45-degree field of view.
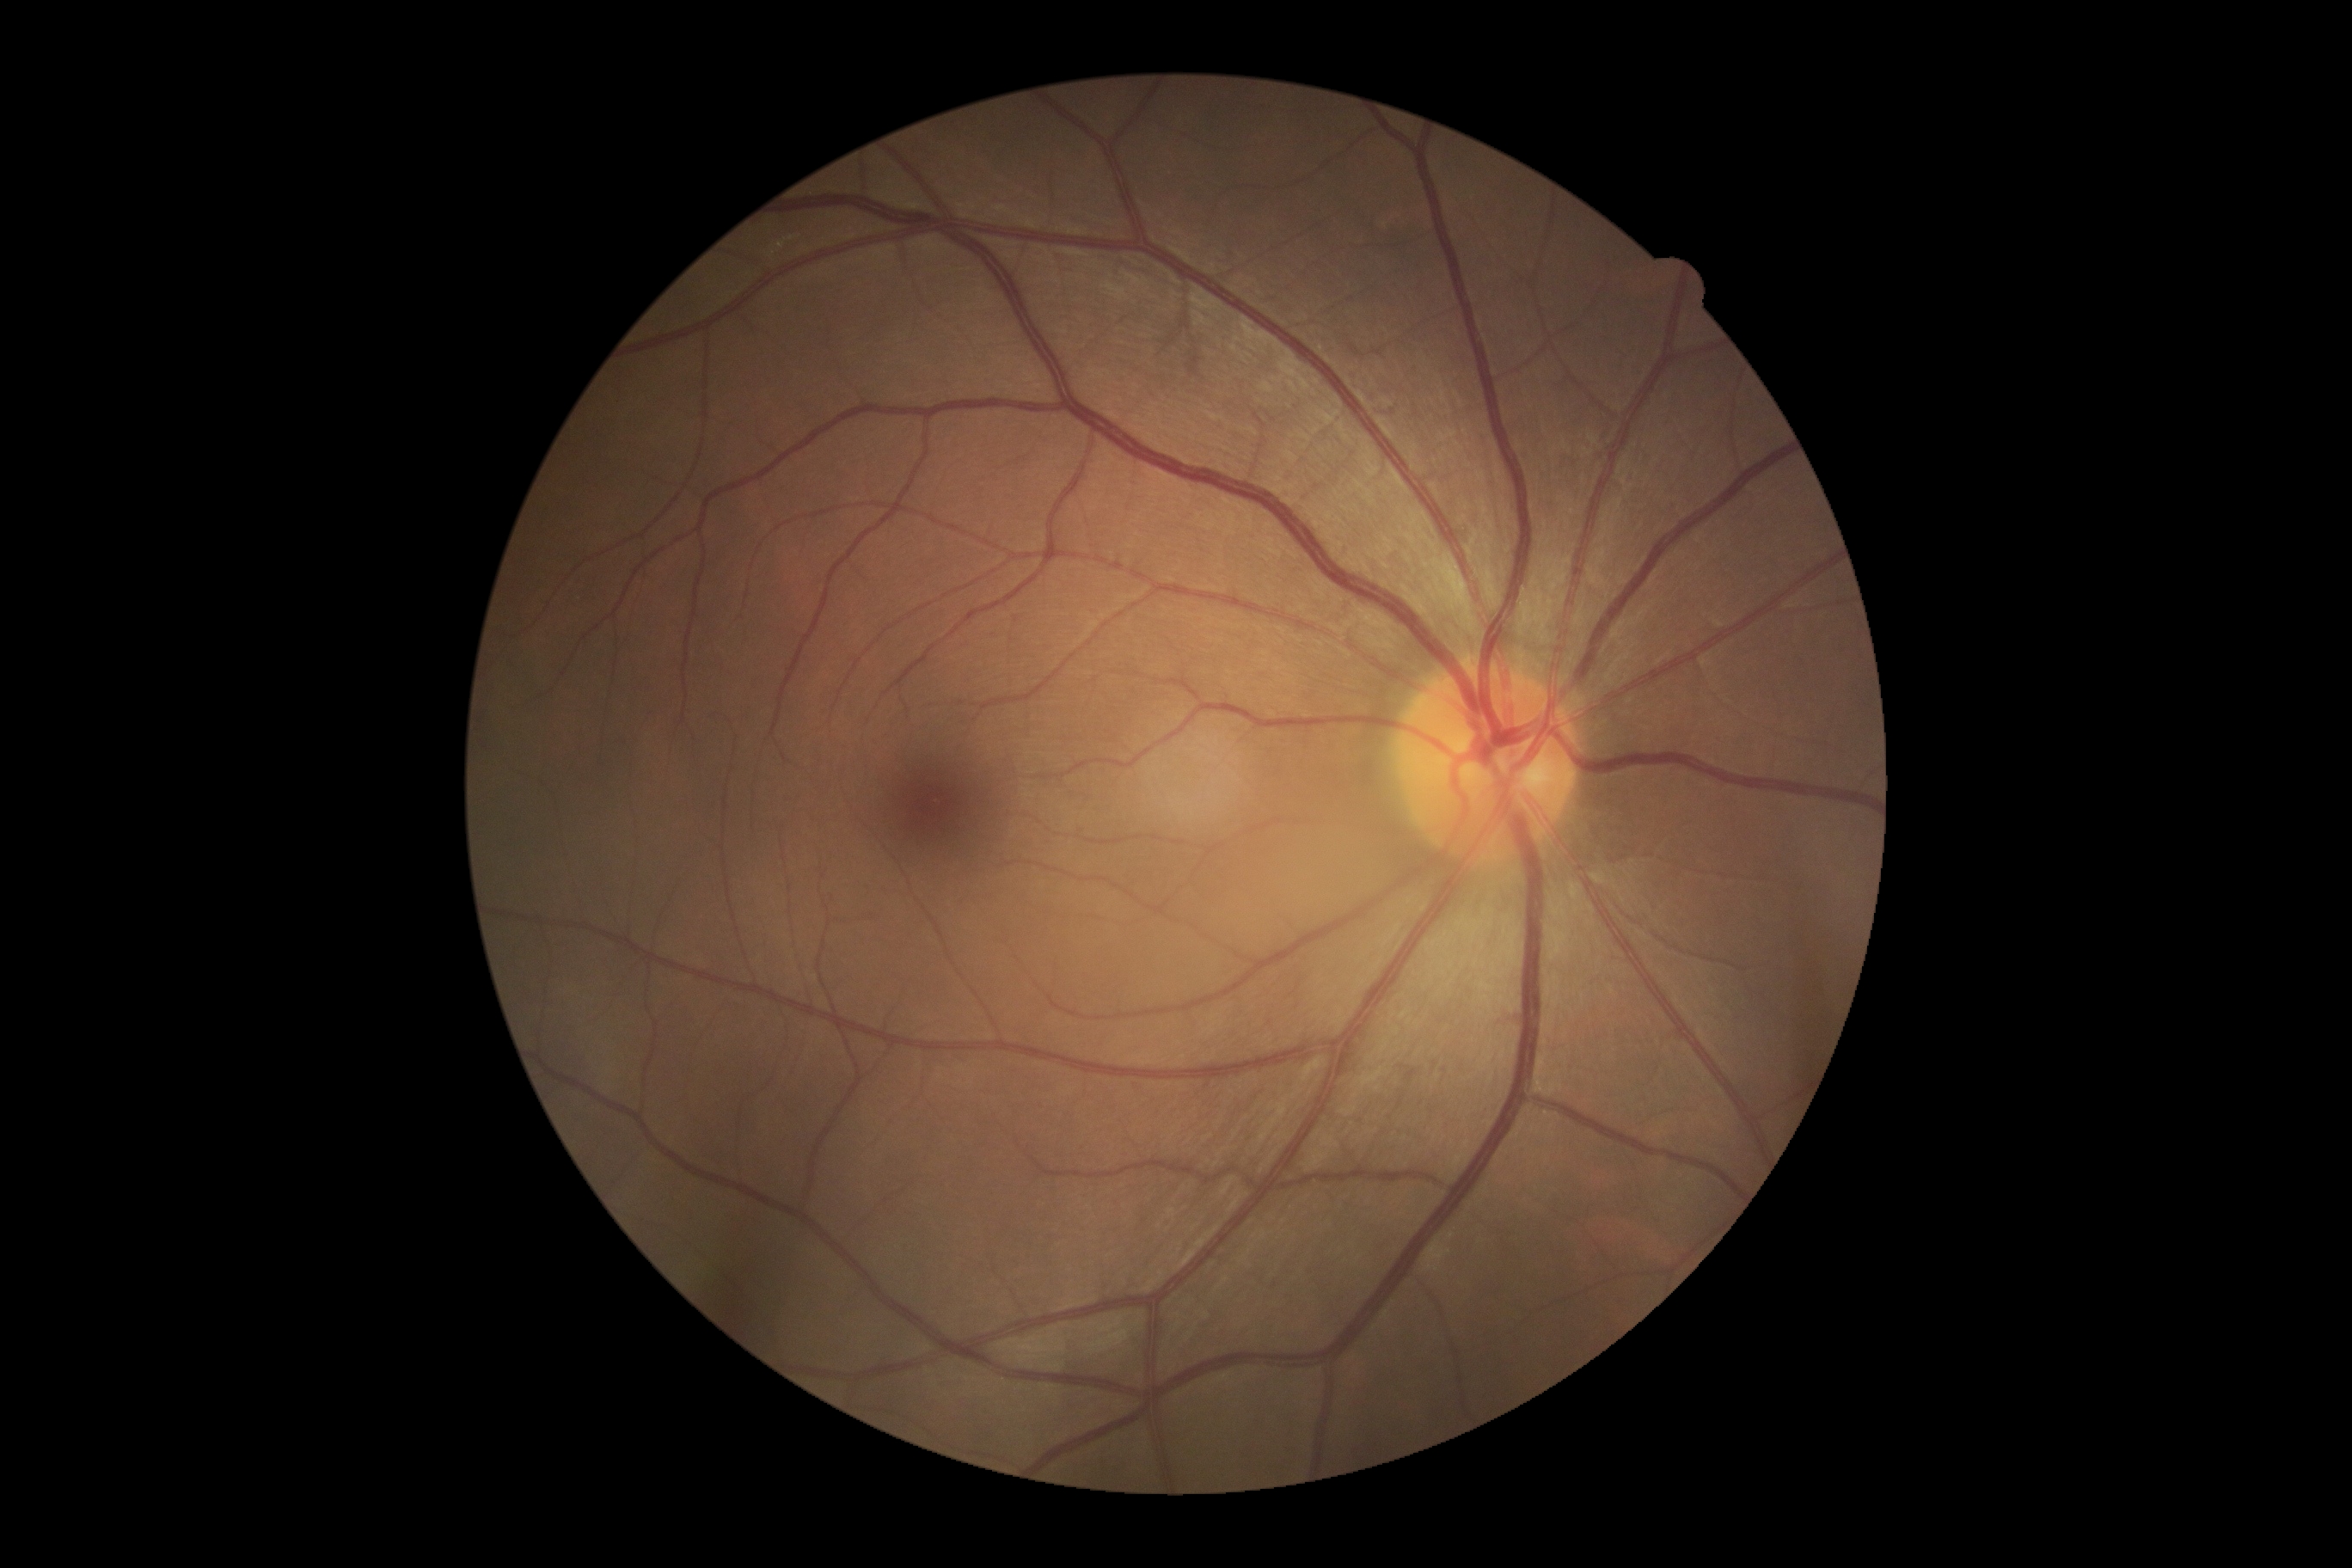
DR=grade 0 (no apparent retinopathy).